FOV: 45 degrees: 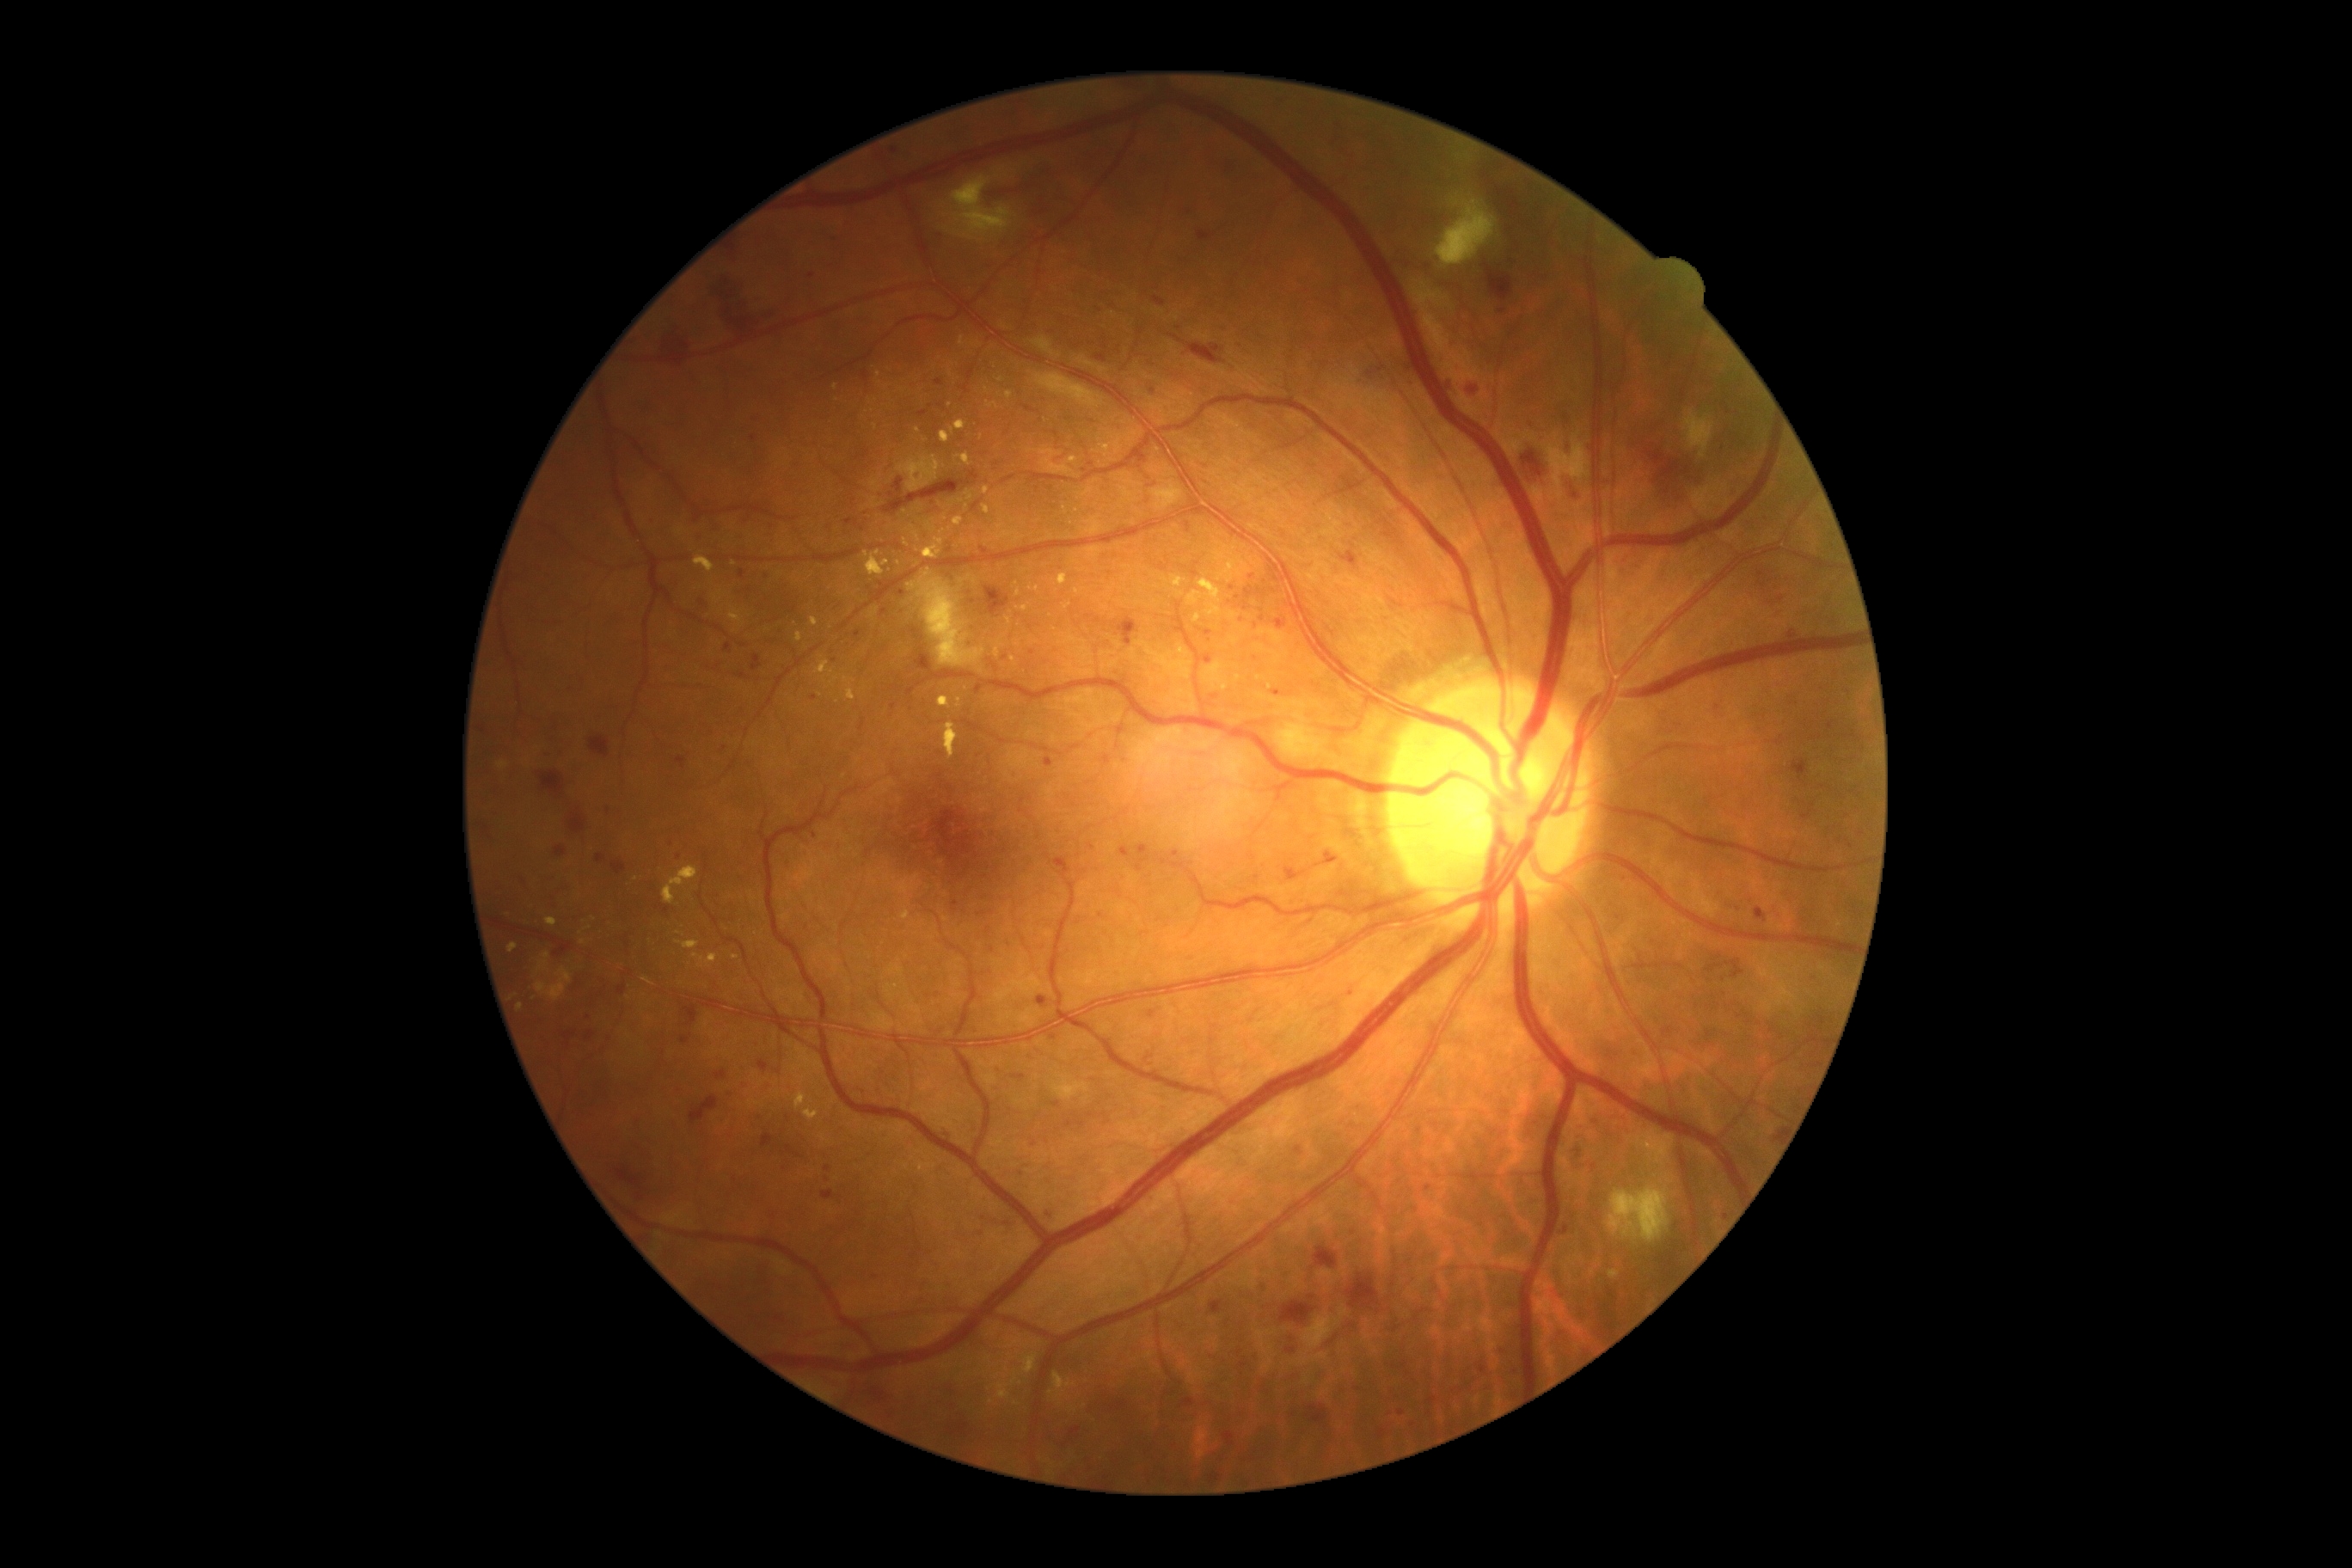 Diabetic retinopathy (DR) is 3
Representative lesions:
microaneurysms (MAs) (more not shown): bbox=[754, 1112, 763, 1118], bbox=[1046, 757, 1053, 768], bbox=[1172, 852, 1180, 859], bbox=[976, 683, 983, 695]
MAs (small, approximate centers) near x=1401, y=1413, x=754, y=439, x=766, y=579, x=875, y=1277, x=1237, y=345, x=1252, y=577, x=753, y=416, x=1429, y=1188, x=950, y=551, x=939, y=382, x=1152, y=392, x=1033, y=653